Infant wide-field retinal image — 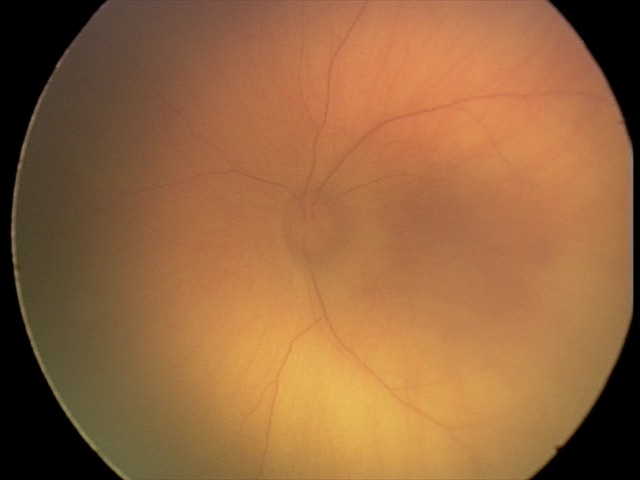
Screening: retinal hemorrhages.